Pediatric wide-field fundus photograph: 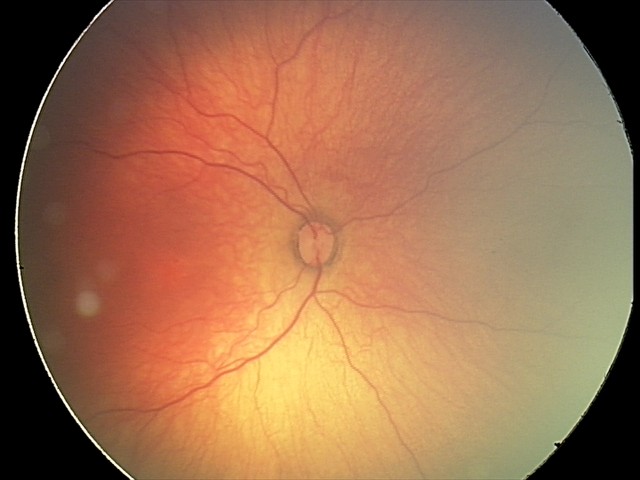

Plus disease absent.
Series diagnosed as status post retinopathy of prematurity.